Image size 2352x1568, color fundus photograph.
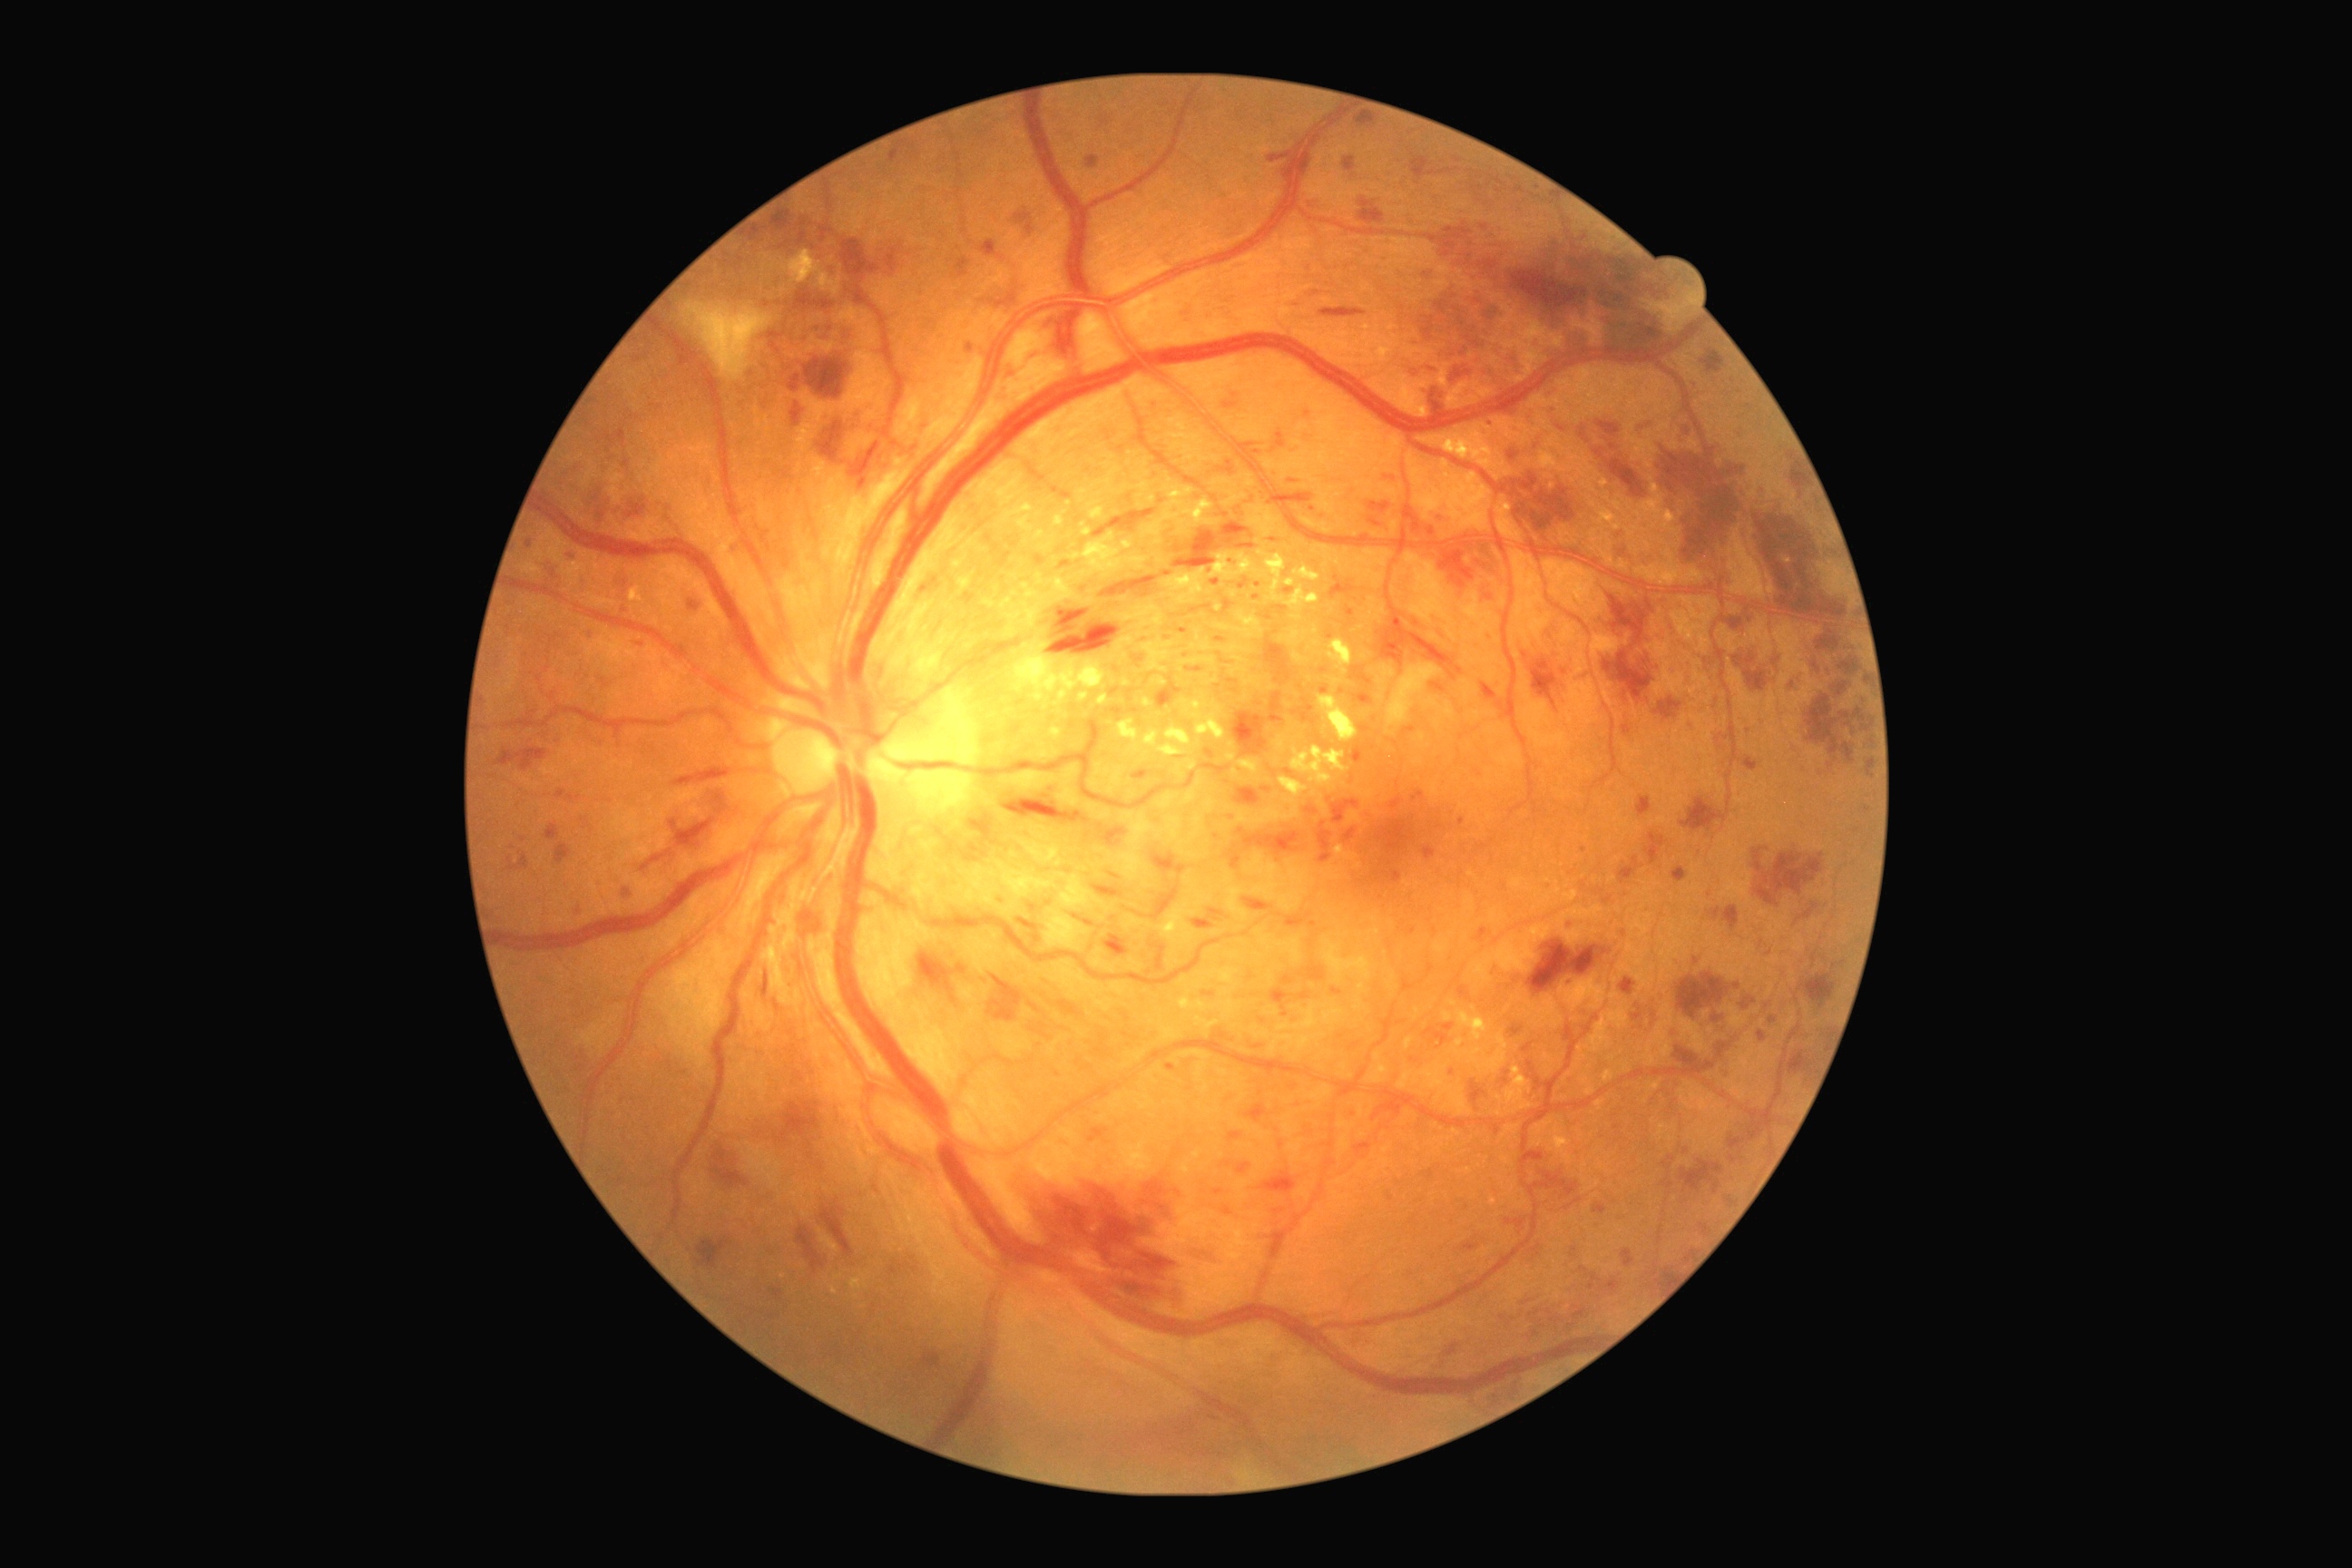

Diabetic retinopathy (DR): severe NPDR (grade 3)
A subset of detected lesions:
- microaneurysms (MAs) (continued): (left=1413, top=790, right=1426, bottom=801) | (left=1346, top=607, right=1355, bottom=616) | (left=1433, top=616, right=1442, bottom=627) | (left=1685, top=427, right=1690, bottom=435) | (left=1269, top=692, right=1284, bottom=723) | (left=1308, top=201, right=1318, bottom=208) | (left=1353, top=747, right=1364, bottom=765) | (left=1133, top=770, right=1150, bottom=781) | (left=1462, top=1235, right=1480, bottom=1251) | (left=1211, top=580, right=1220, bottom=585) | (left=1215, top=638, right=1226, bottom=643) | (left=1700, top=1224, right=1709, bottom=1237) | (left=1527, top=1244, right=1542, bottom=1260) | (left=1224, top=1208, right=1233, bottom=1215)
- Small MAs approximately at x=1140, y=660 | x=1856, y=831 | x=1217, y=837 | x=1307, y=413 | x=1274, y=541
- hemorrhages (HEs) (continued): (left=1416, top=534, right=1509, bottom=591) | (left=1237, top=544, right=1255, bottom=549) | (left=885, top=244, right=905, bottom=273) | (left=605, top=429, right=625, bottom=447) | (left=772, top=211, right=792, bottom=231) | (left=1867, top=760, right=1876, bottom=778) | (left=1674, top=1046, right=1716, bottom=1077) | (left=790, top=905, right=823, bottom=941) | (left=1505, top=974, right=1520, bottom=992) | (left=1152, top=854, right=1188, bottom=874) | (left=821, top=1199, right=854, bottom=1257) | (left=988, top=975, right=1023, bottom=1023) | (left=794, top=291, right=834, bottom=311) | (left=1355, top=113, right=1377, bottom=128) | (left=1235, top=789, right=1260, bottom=807) | (left=1865, top=683, right=1868, bottom=691) | (left=1808, top=696, right=1856, bottom=763)
- Small HEs approximately at x=1659, y=1283